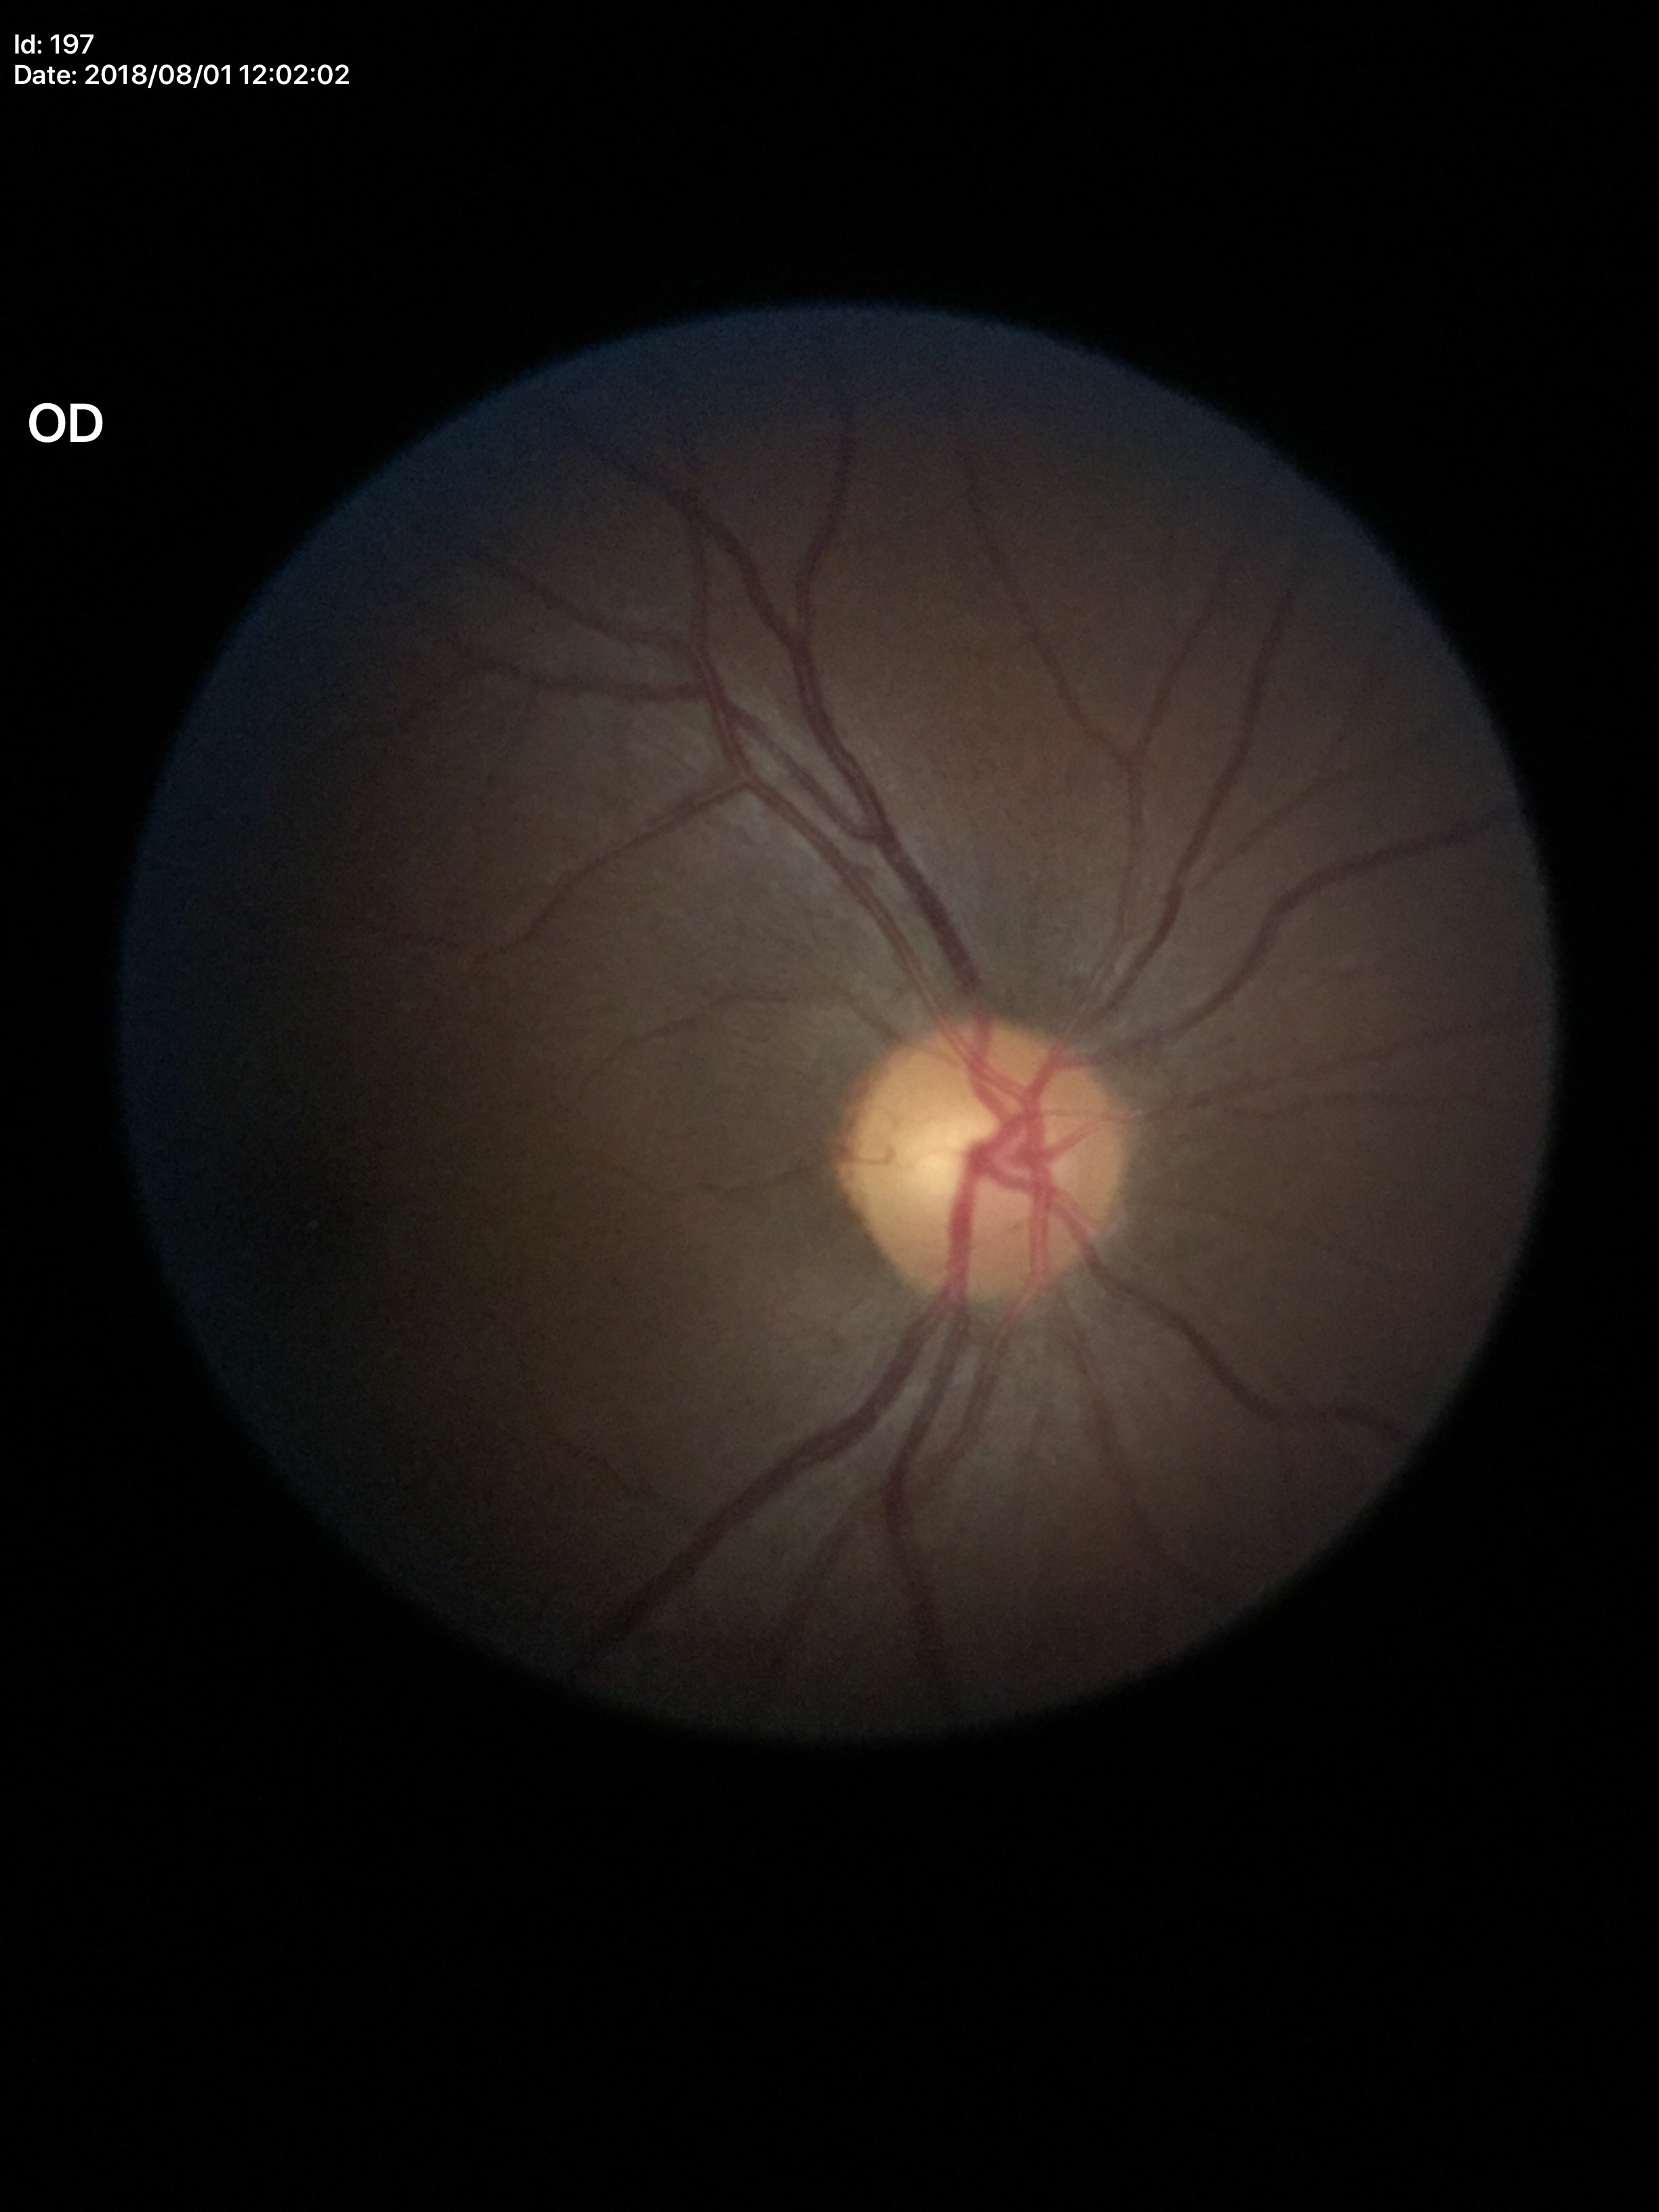
Glaucoma decision = not suspect, vertical CDR = 0.53, horizontal C/D ratio = 0.59.